Graded on the modified Davis scale
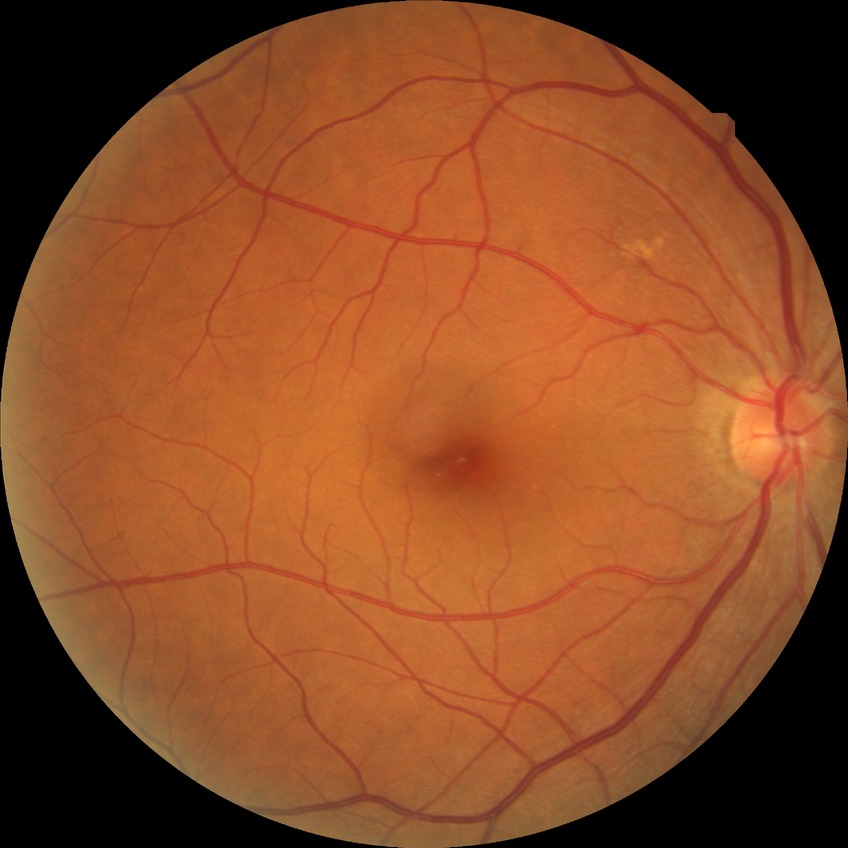

Retinopathy grade: no diabetic retinopathy.